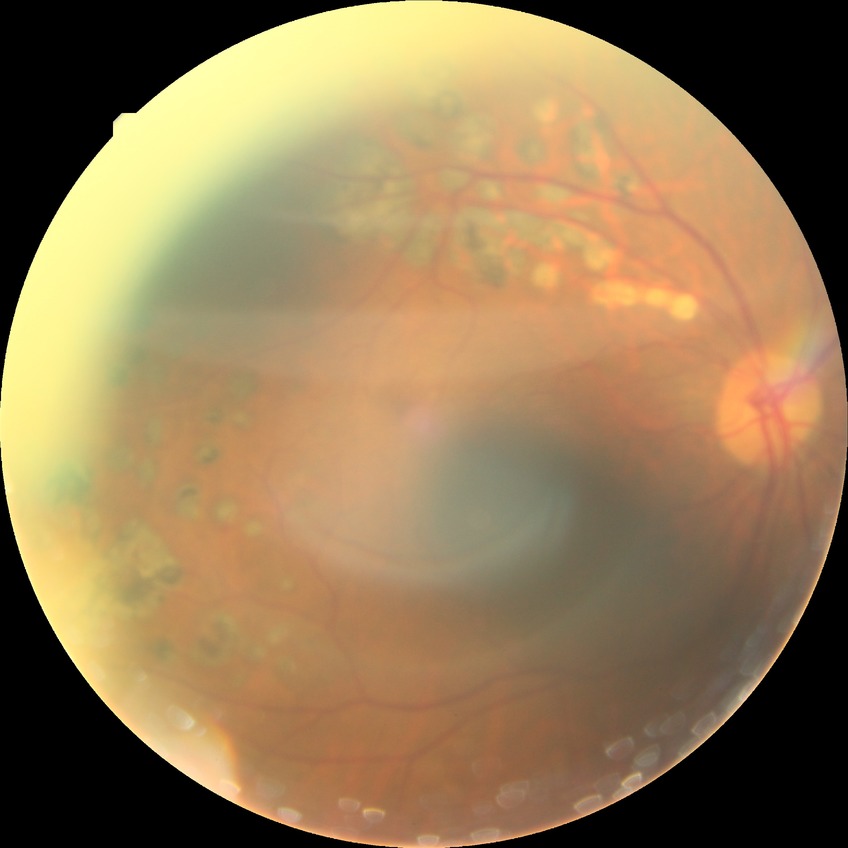
Diabetic retinopathy (DR) is PDR (proliferative diabetic retinopathy).